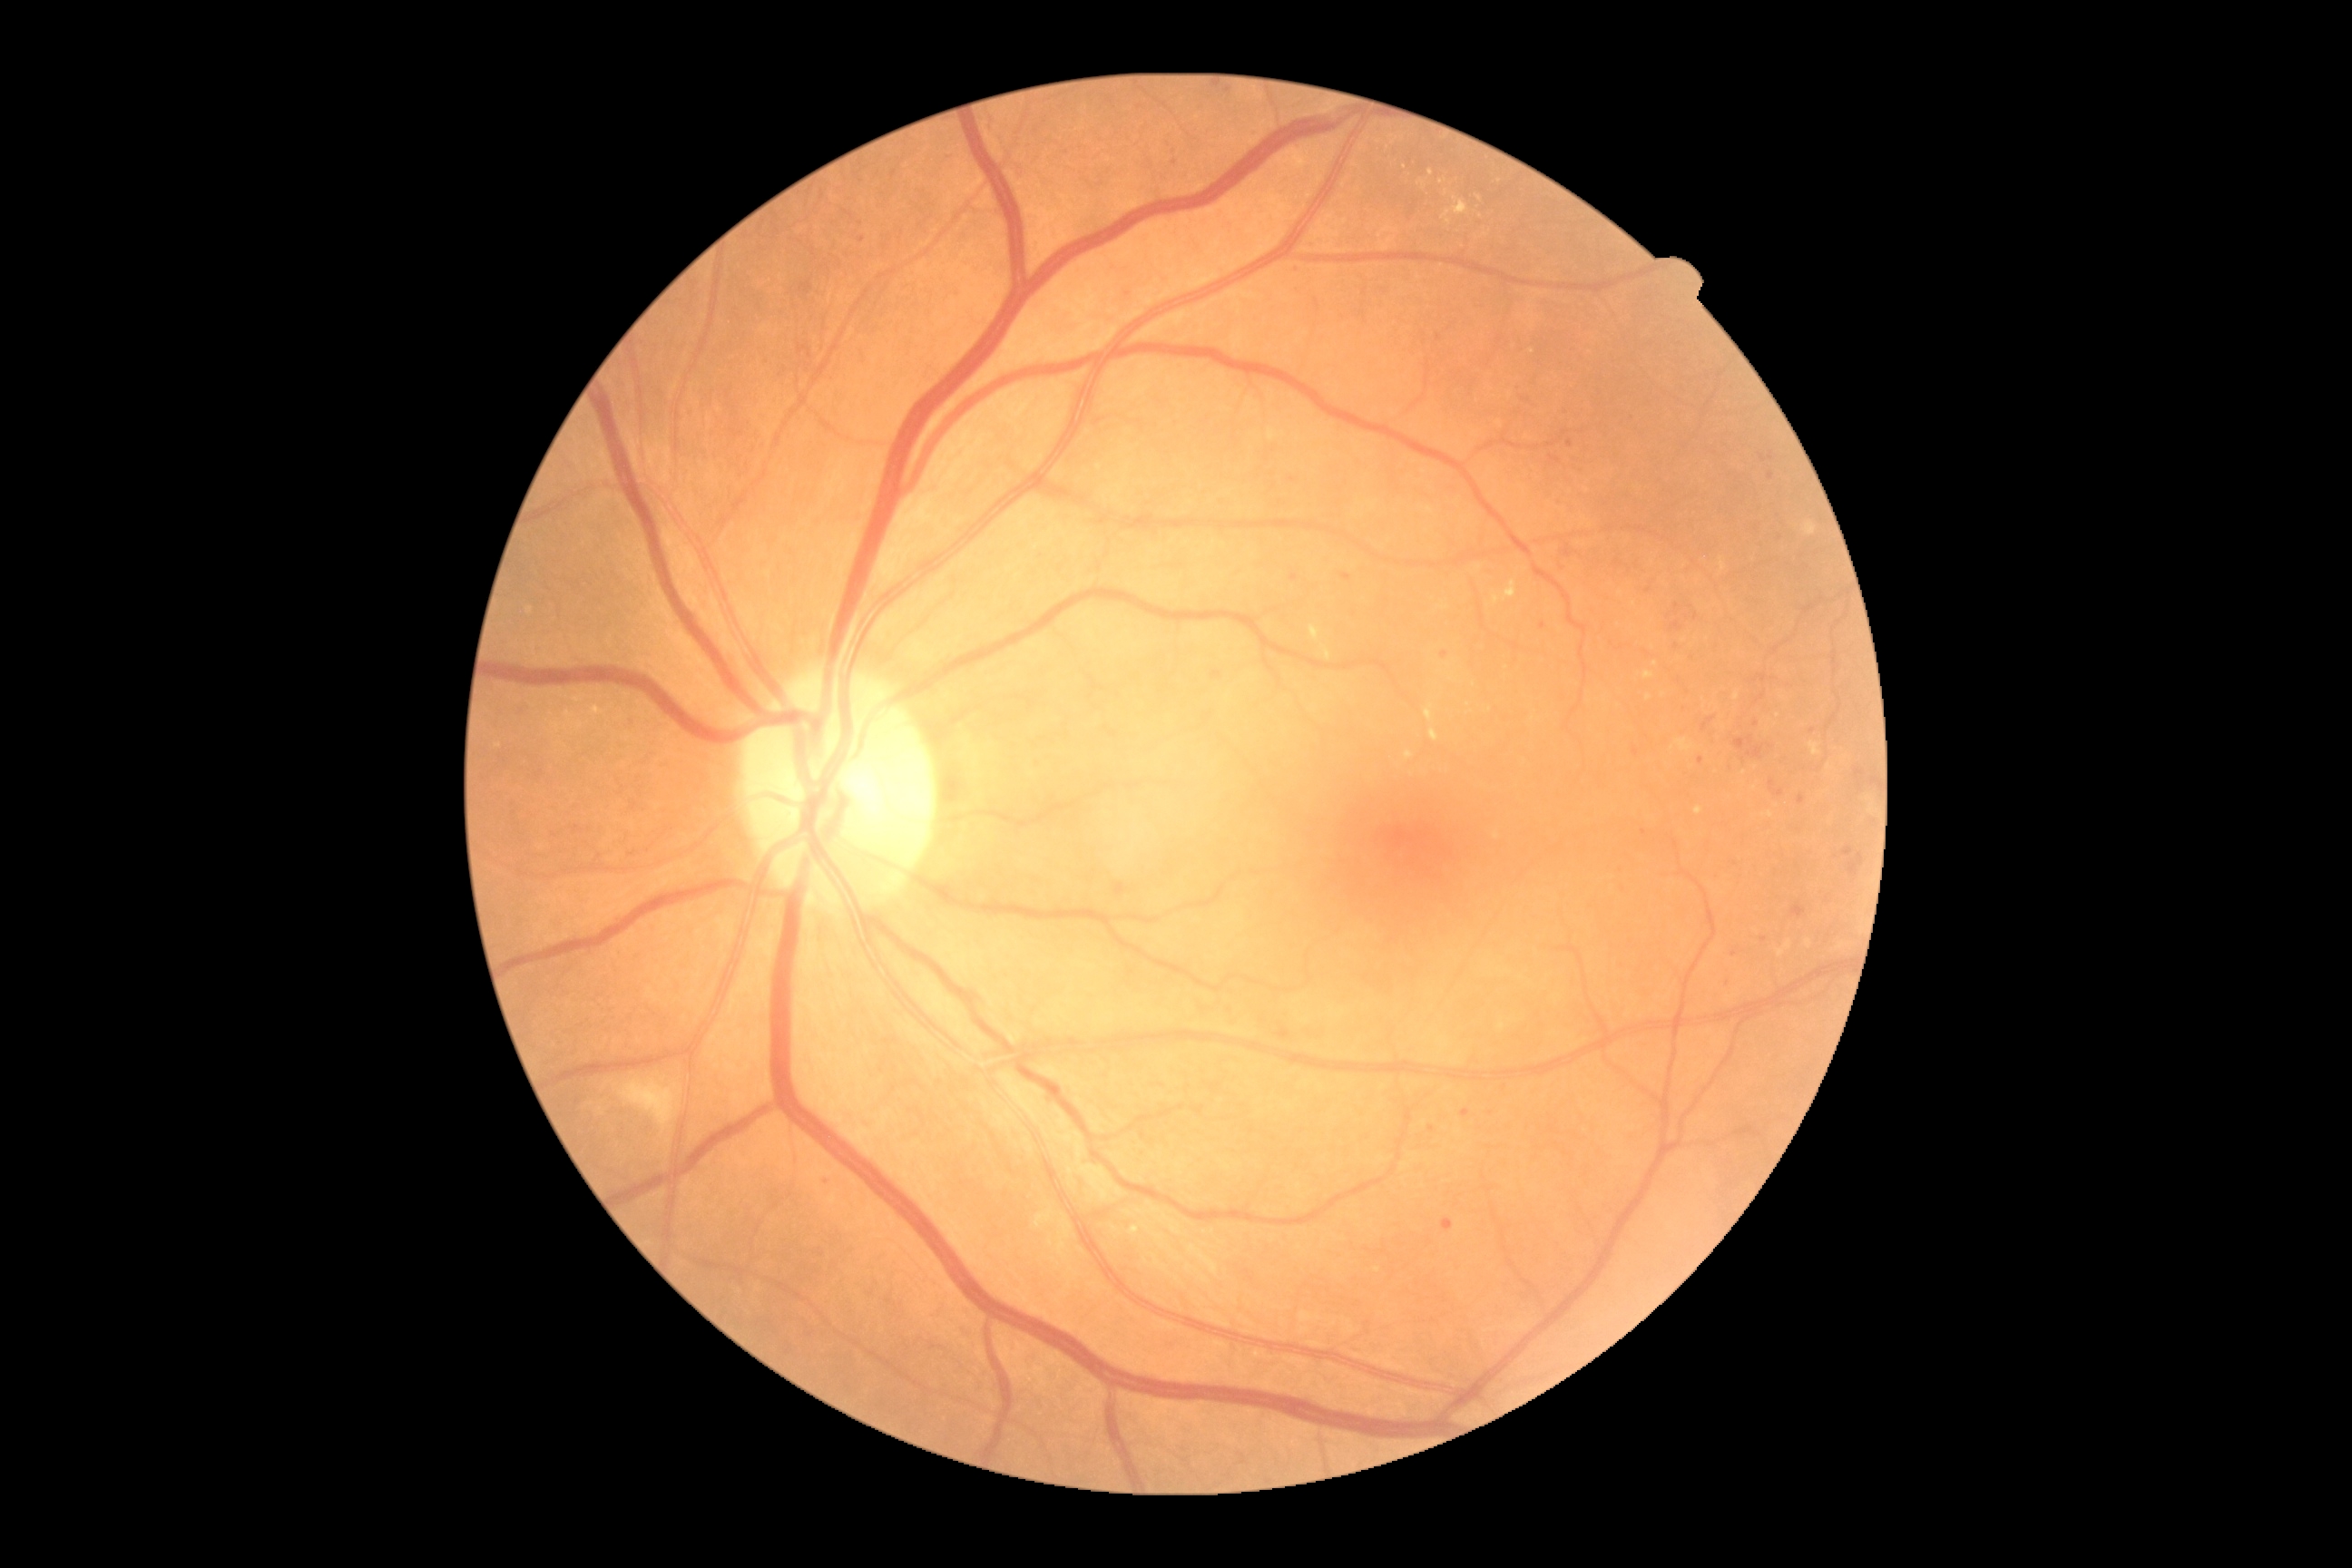 DR grade is 2
Representative lesions:
MAs (subset): BBox(1462, 1110, 1471, 1119); BBox(1769, 781, 1776, 792); BBox(1756, 694, 1767, 703); BBox(1798, 796, 1805, 805); BBox(1792, 903, 1807, 917); BBox(1444, 1219, 1455, 1231); BBox(1634, 749, 1640, 758); BBox(1342, 574, 1351, 582)
Small MAs near 1756:724; 1771:476; 577:828; 1734:954; 1696:617; 1542:626